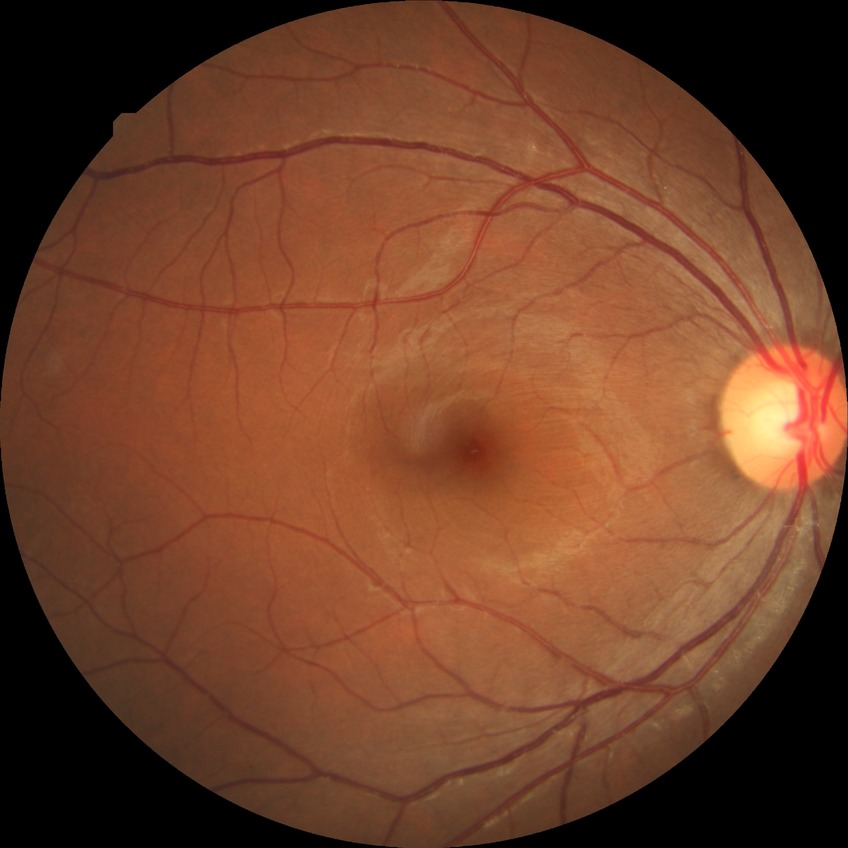
modified Davis grading: no diabetic retinopathy.